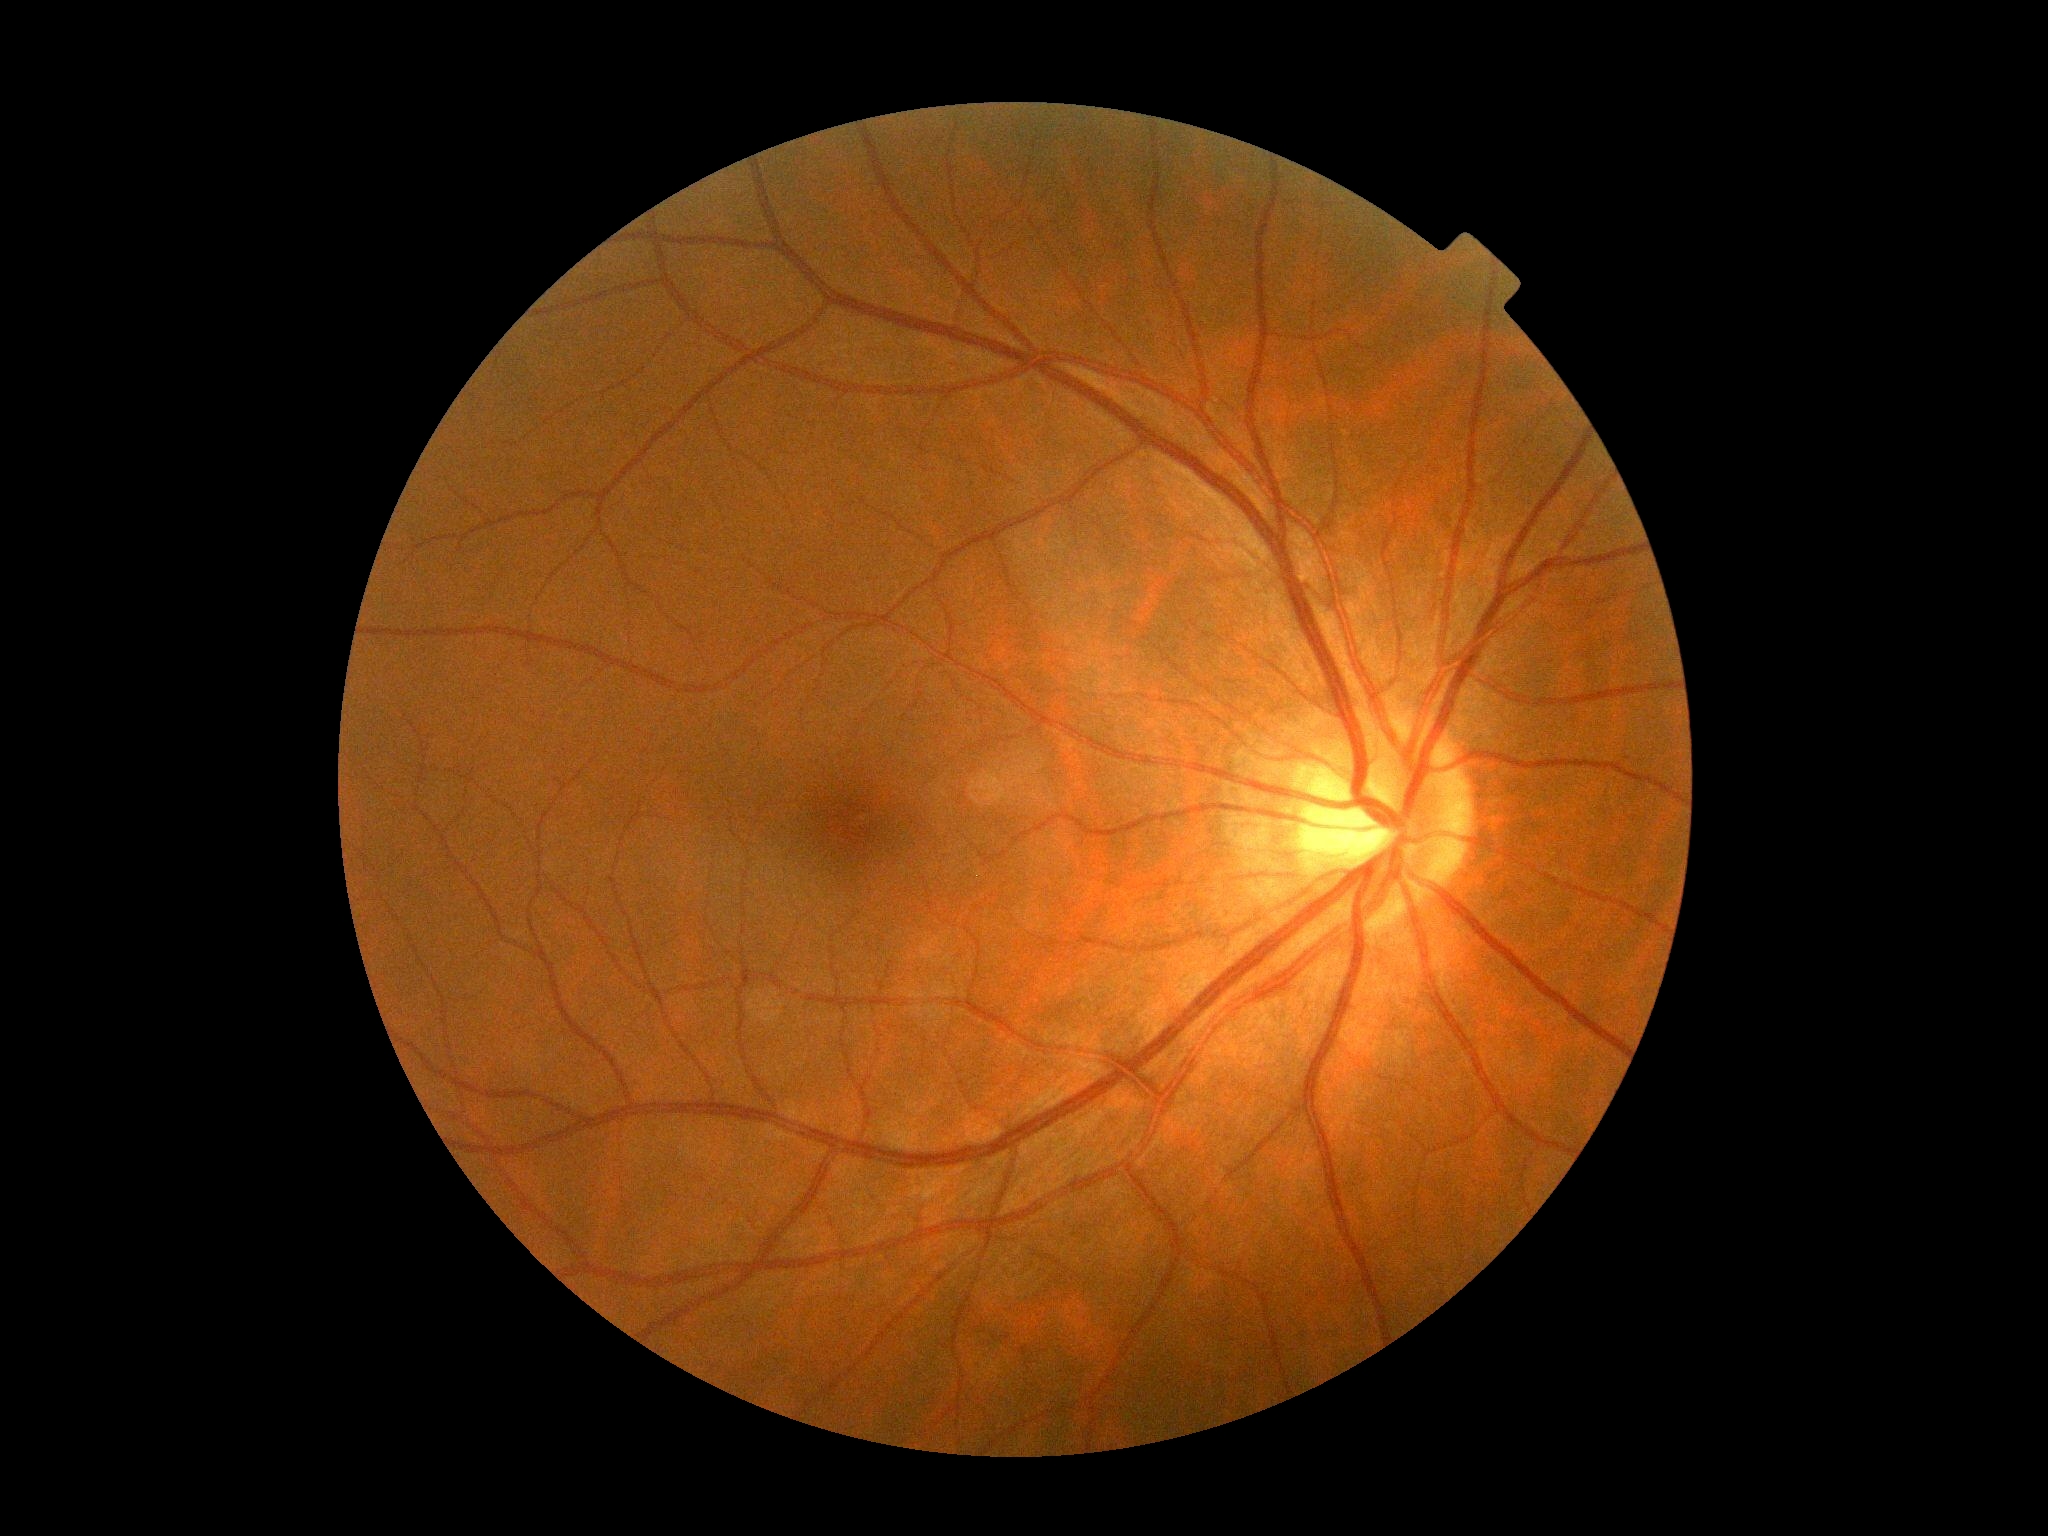
DR impression = no signs of DR | retinopathy grade = 0.